Image size 1240x1240; 100° field of view (Phoenix ICON); Phoenix ICON wide-field infant fundus image: 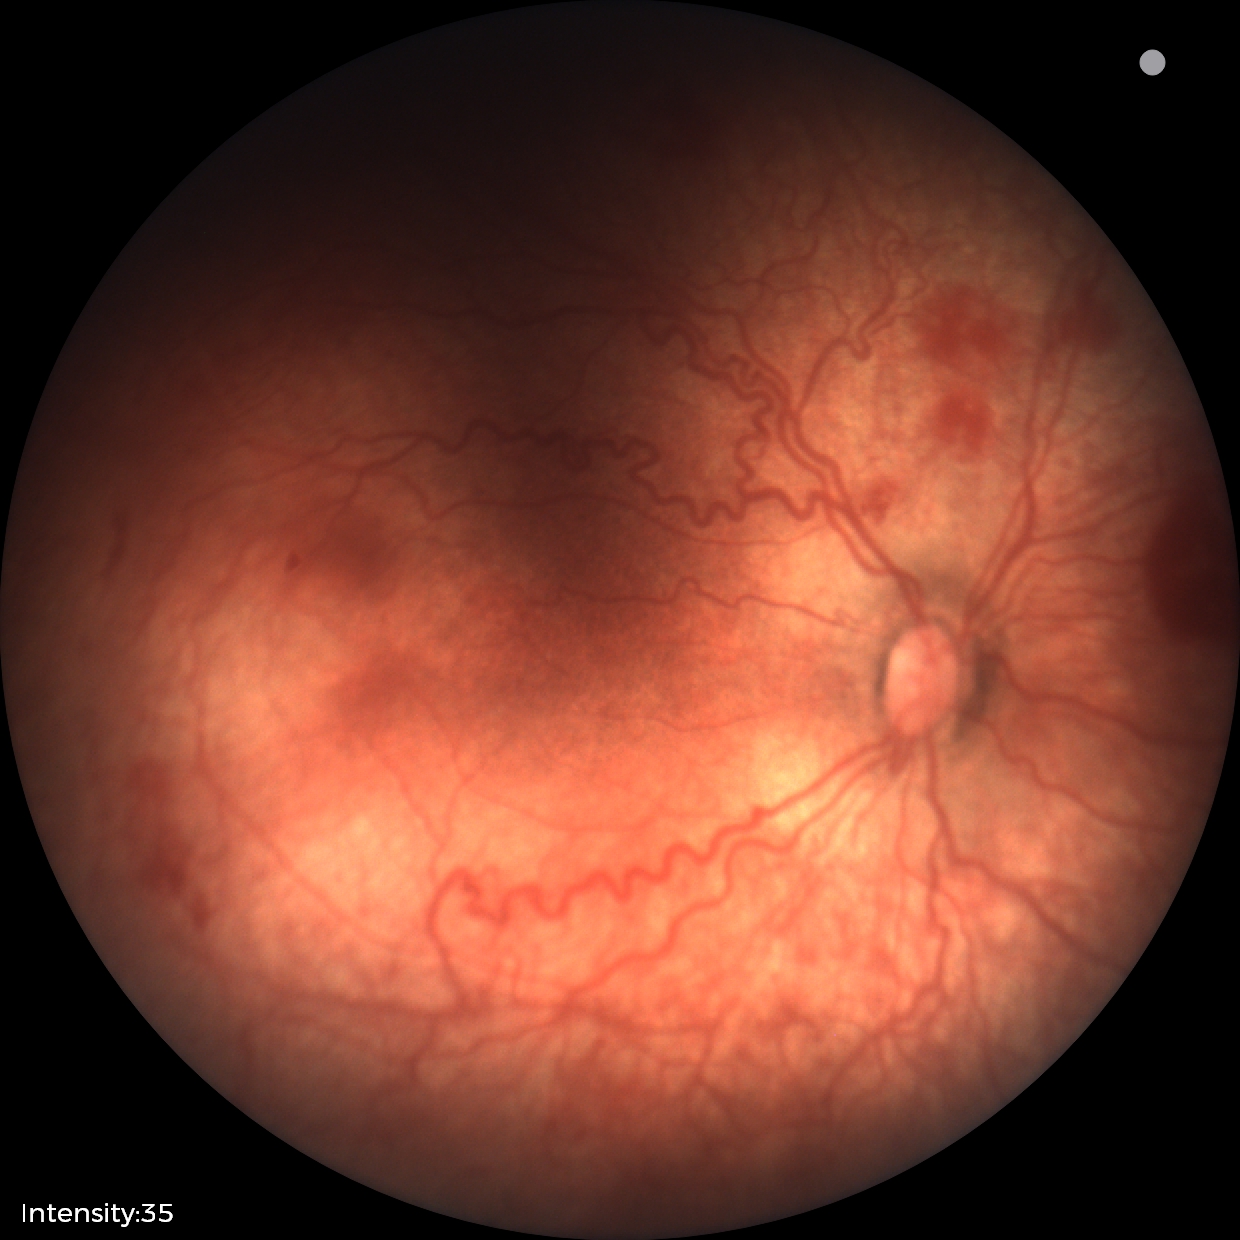
Screening series with retinopathy of prematurity stage 2. With plus disease.